848x848; 45 degree fundus photograph; nonmydriatic; camera: NIDEK AFC-230
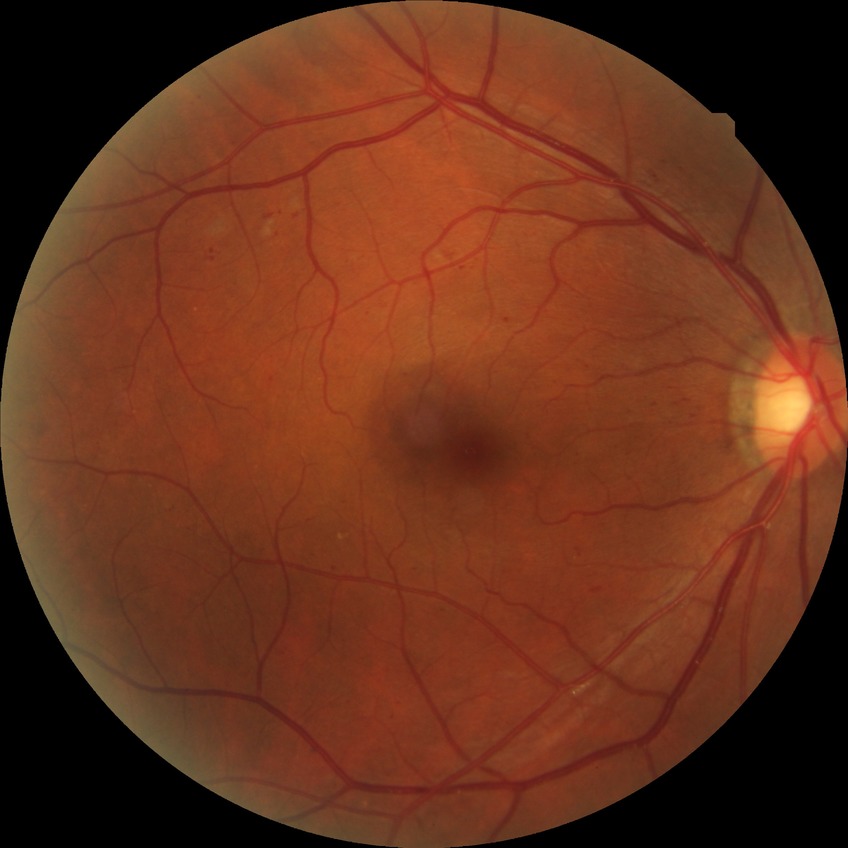
Davis grading = simple diabetic retinopathy.